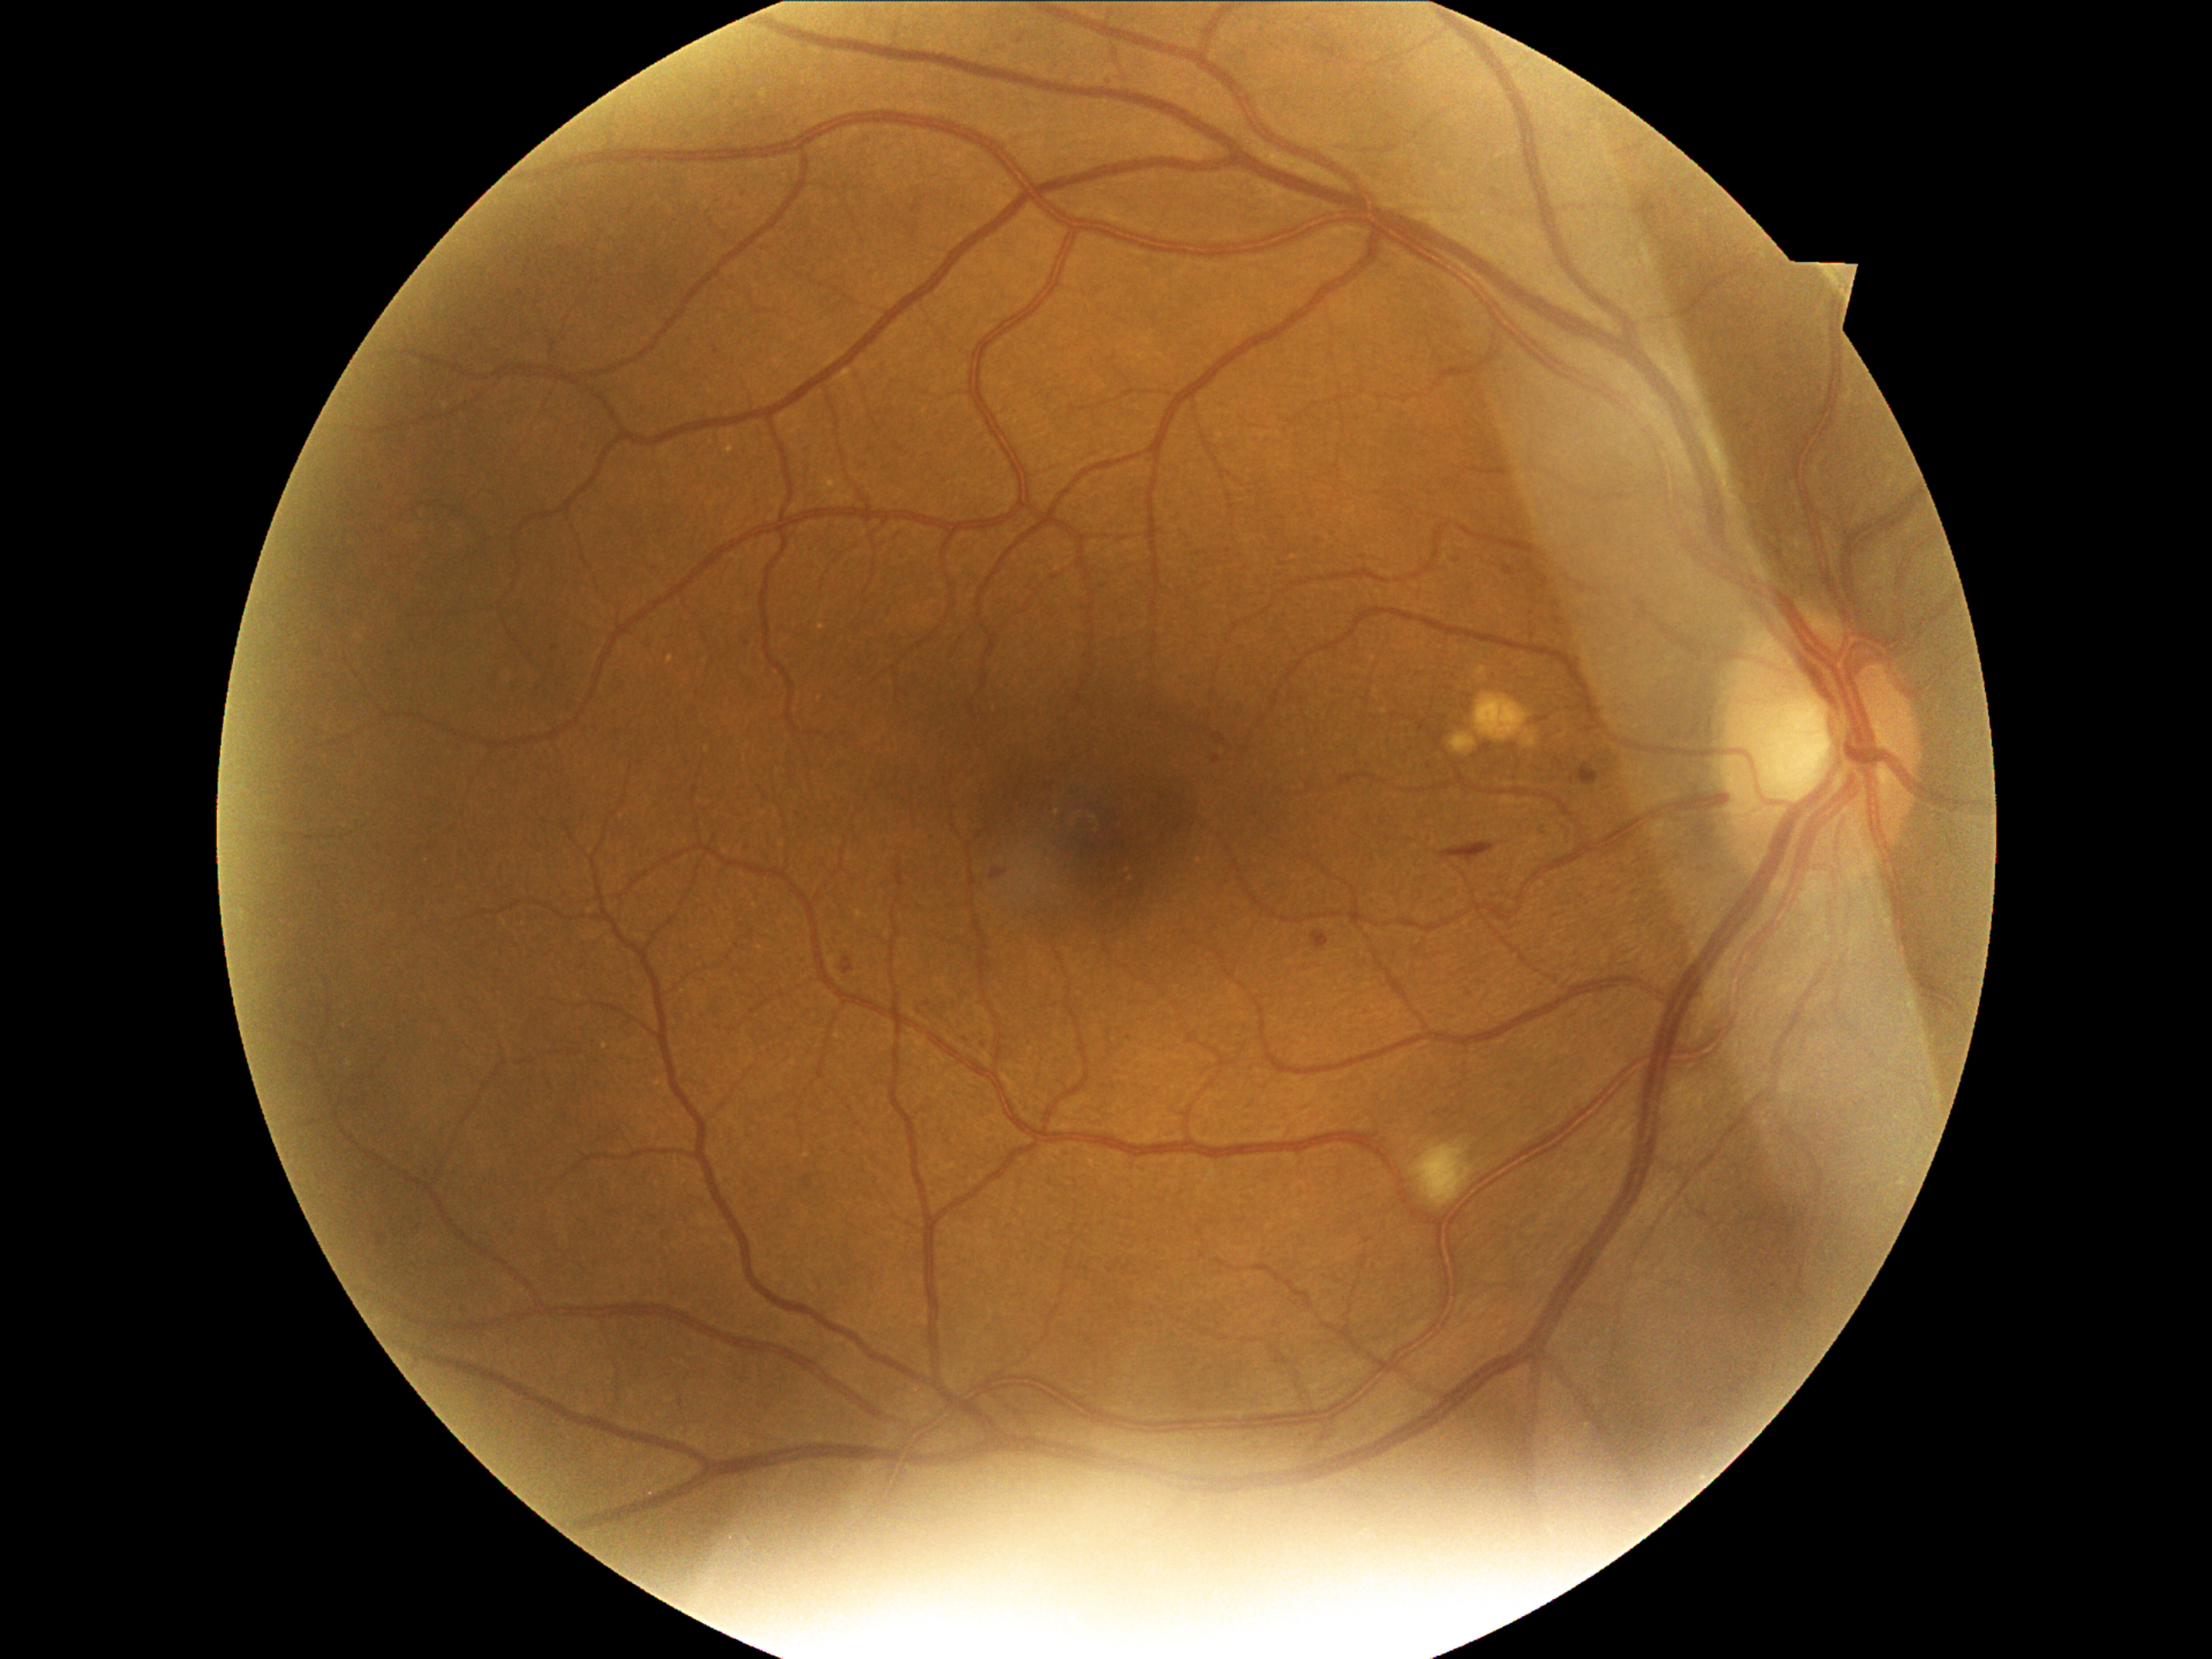 {"partial":true,"dr_grade":2,"lesions":{"ex":null,"he":[[1453,839,1498,858],[1312,931,1330,952],[1581,764,1602,784]],"se":[[1411,1141,1476,1209]],"ma":[[1742,424,1754,431],[1016,35,1030,50],[1450,559,1465,568],[1537,824,1547,835],[1773,1284,1783,1293],[376,1233,388,1247],[738,185,748,197],[839,958,856,975],[1549,597,1559,607],[991,870,1004,880],[1921,591,1930,602],[1213,757,1221,764],[1544,578,1552,585],[1505,566,1520,578]],"ma_small":[[747,643],[554,647],[1559,621]]}}